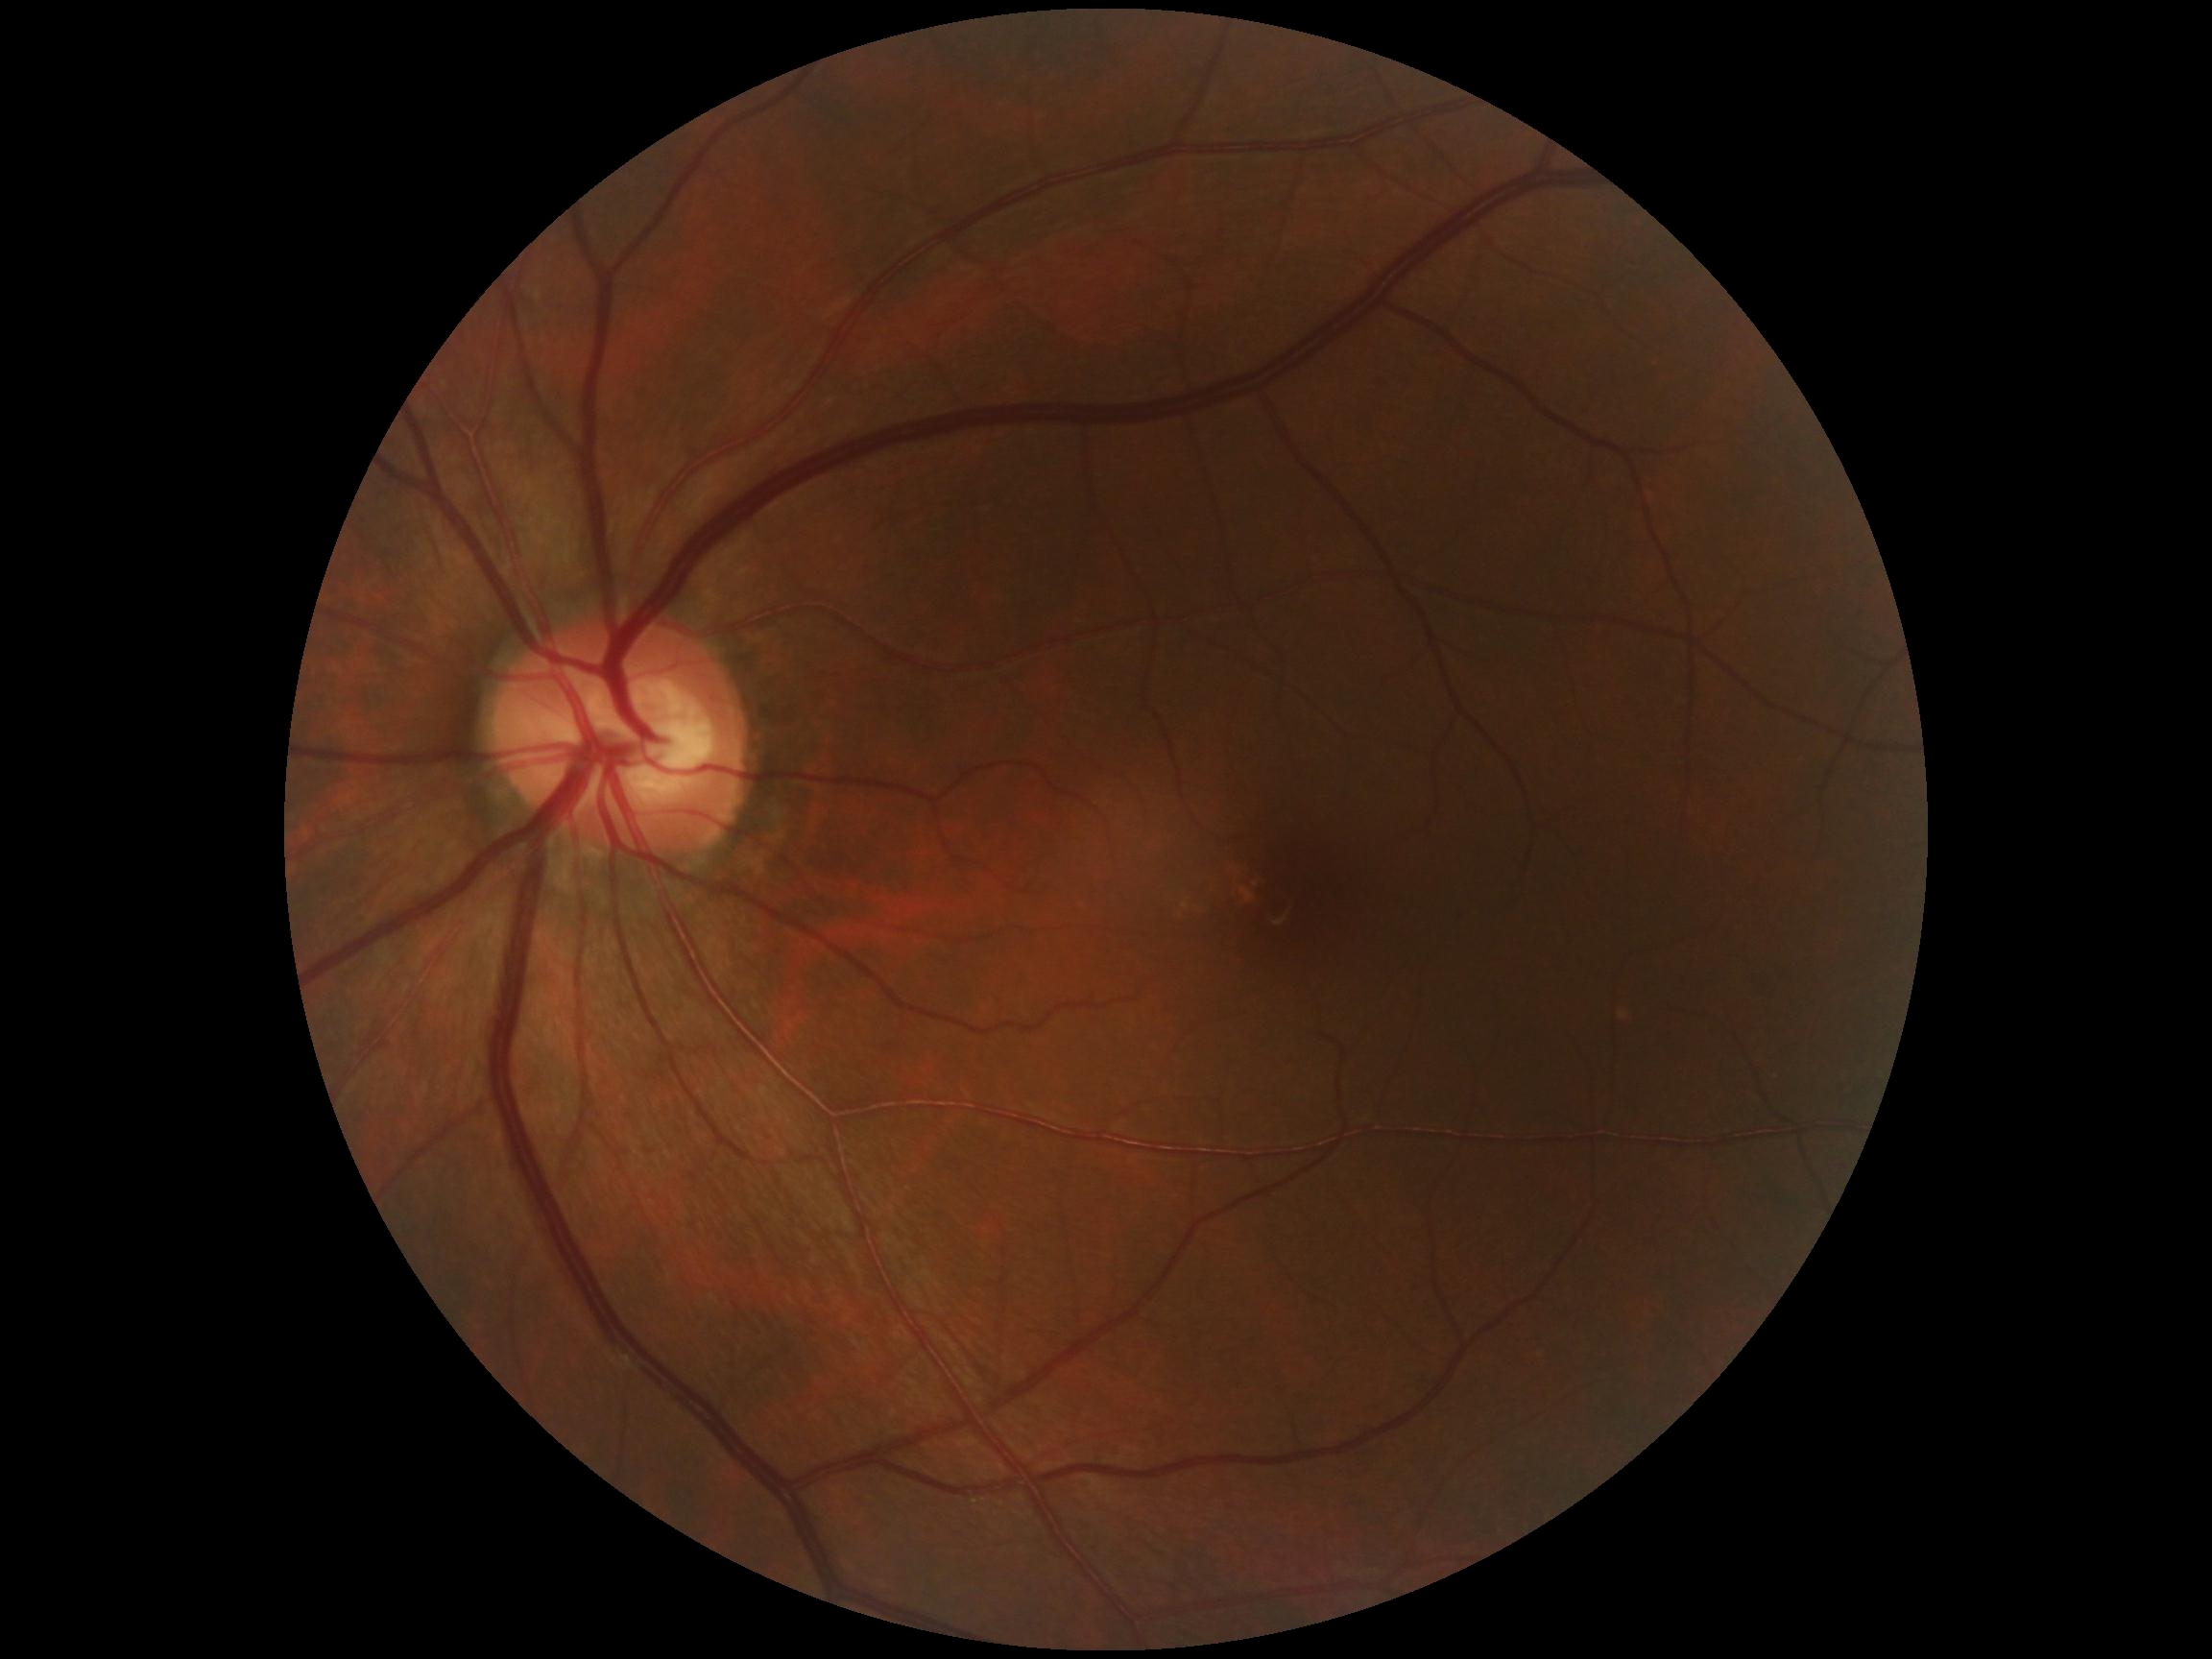 Diabetic retinopathy severity: 0.